CFP: 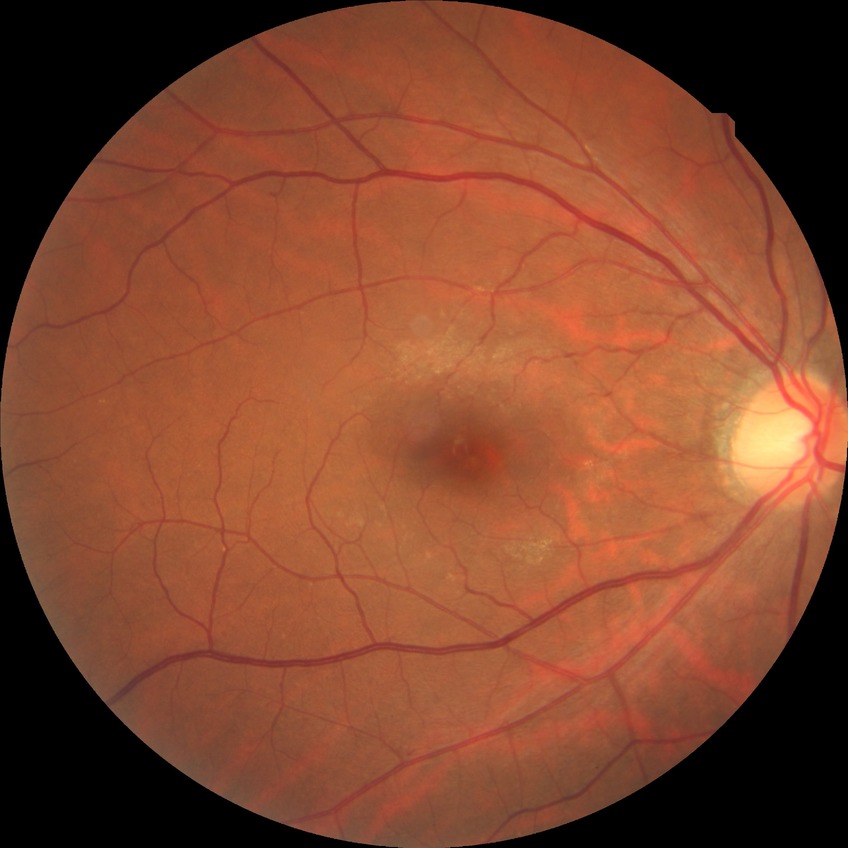

Diabetic retinopathy (DR) is NDR (no diabetic retinopathy).